UWF retinal mosaic — 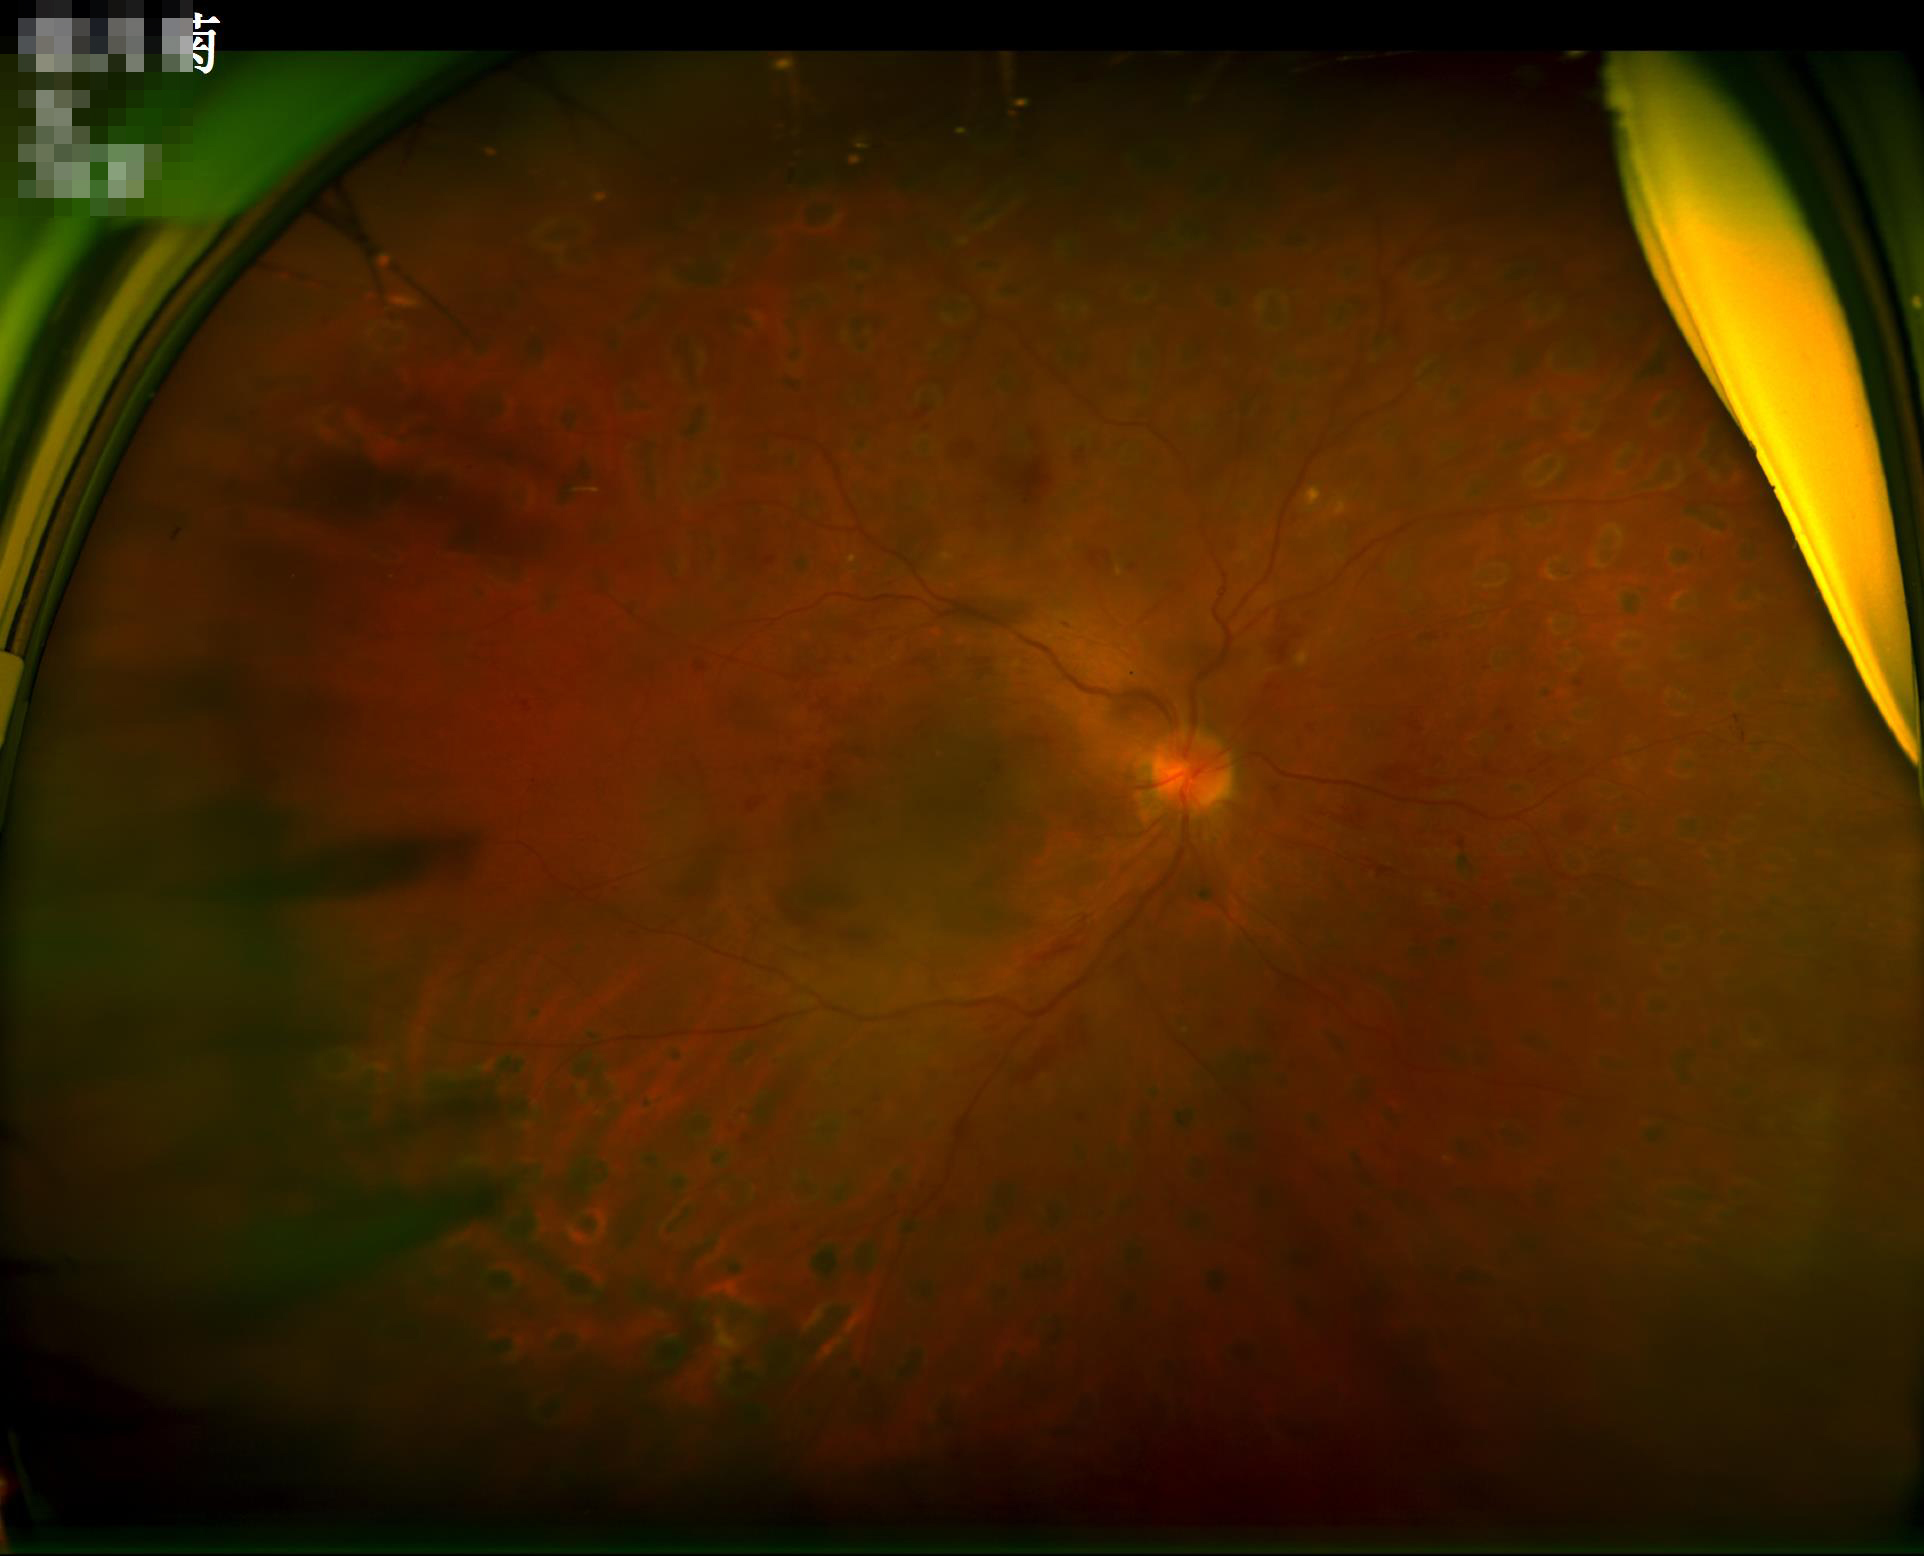

  contrast: vessels and details readily distinguishable
  illumination: uneven illumination or color cast
  clarity: clear with no noticeable blur
  overall_quality: poor and difficult to use diagnostically